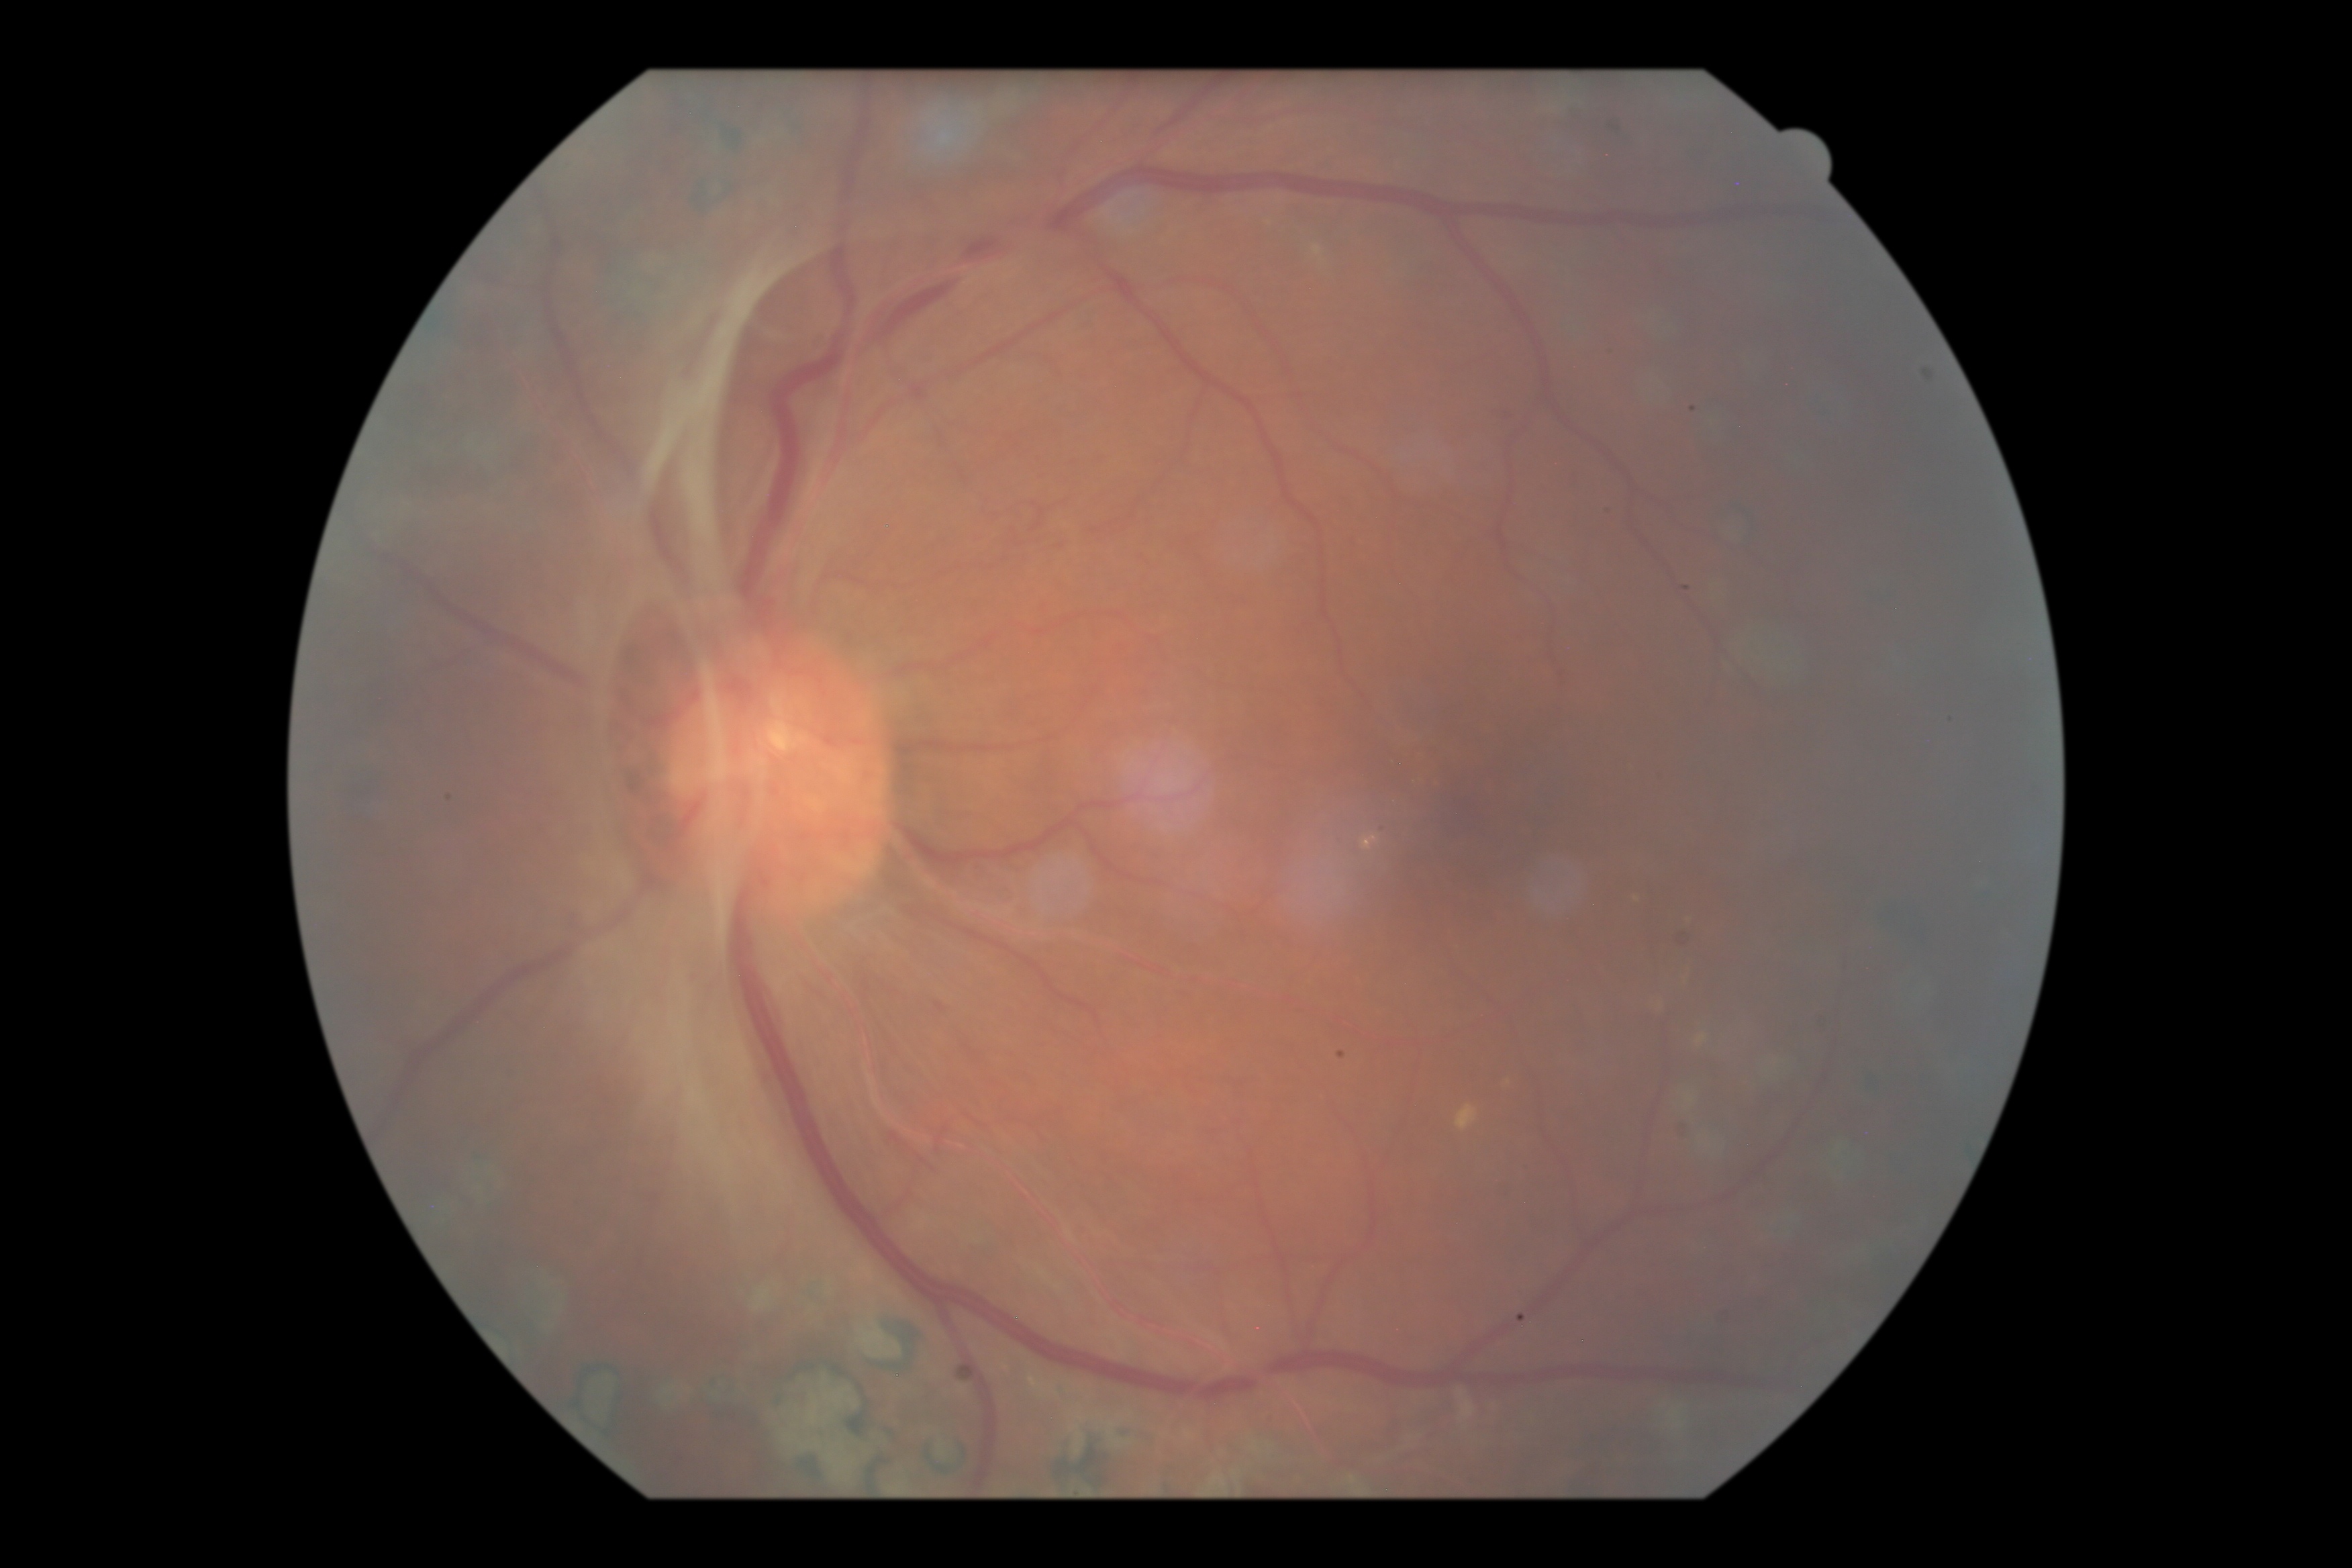
DR grade: 4/4.